DR severity per modified Davis staging.
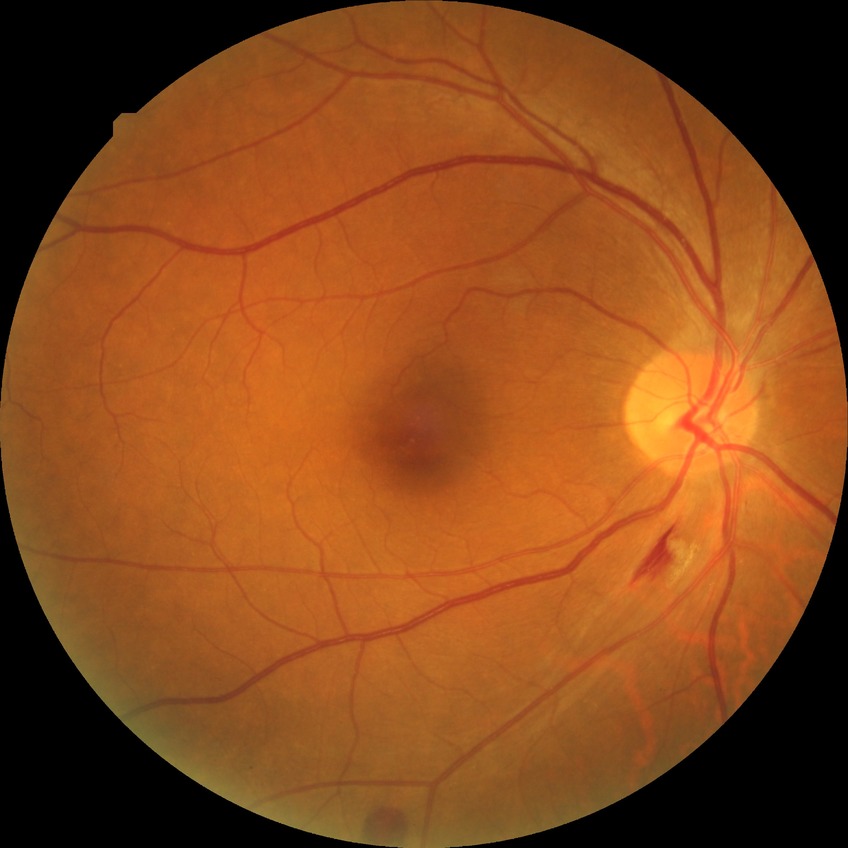 Assessment:
- Davis DR grade — SDR